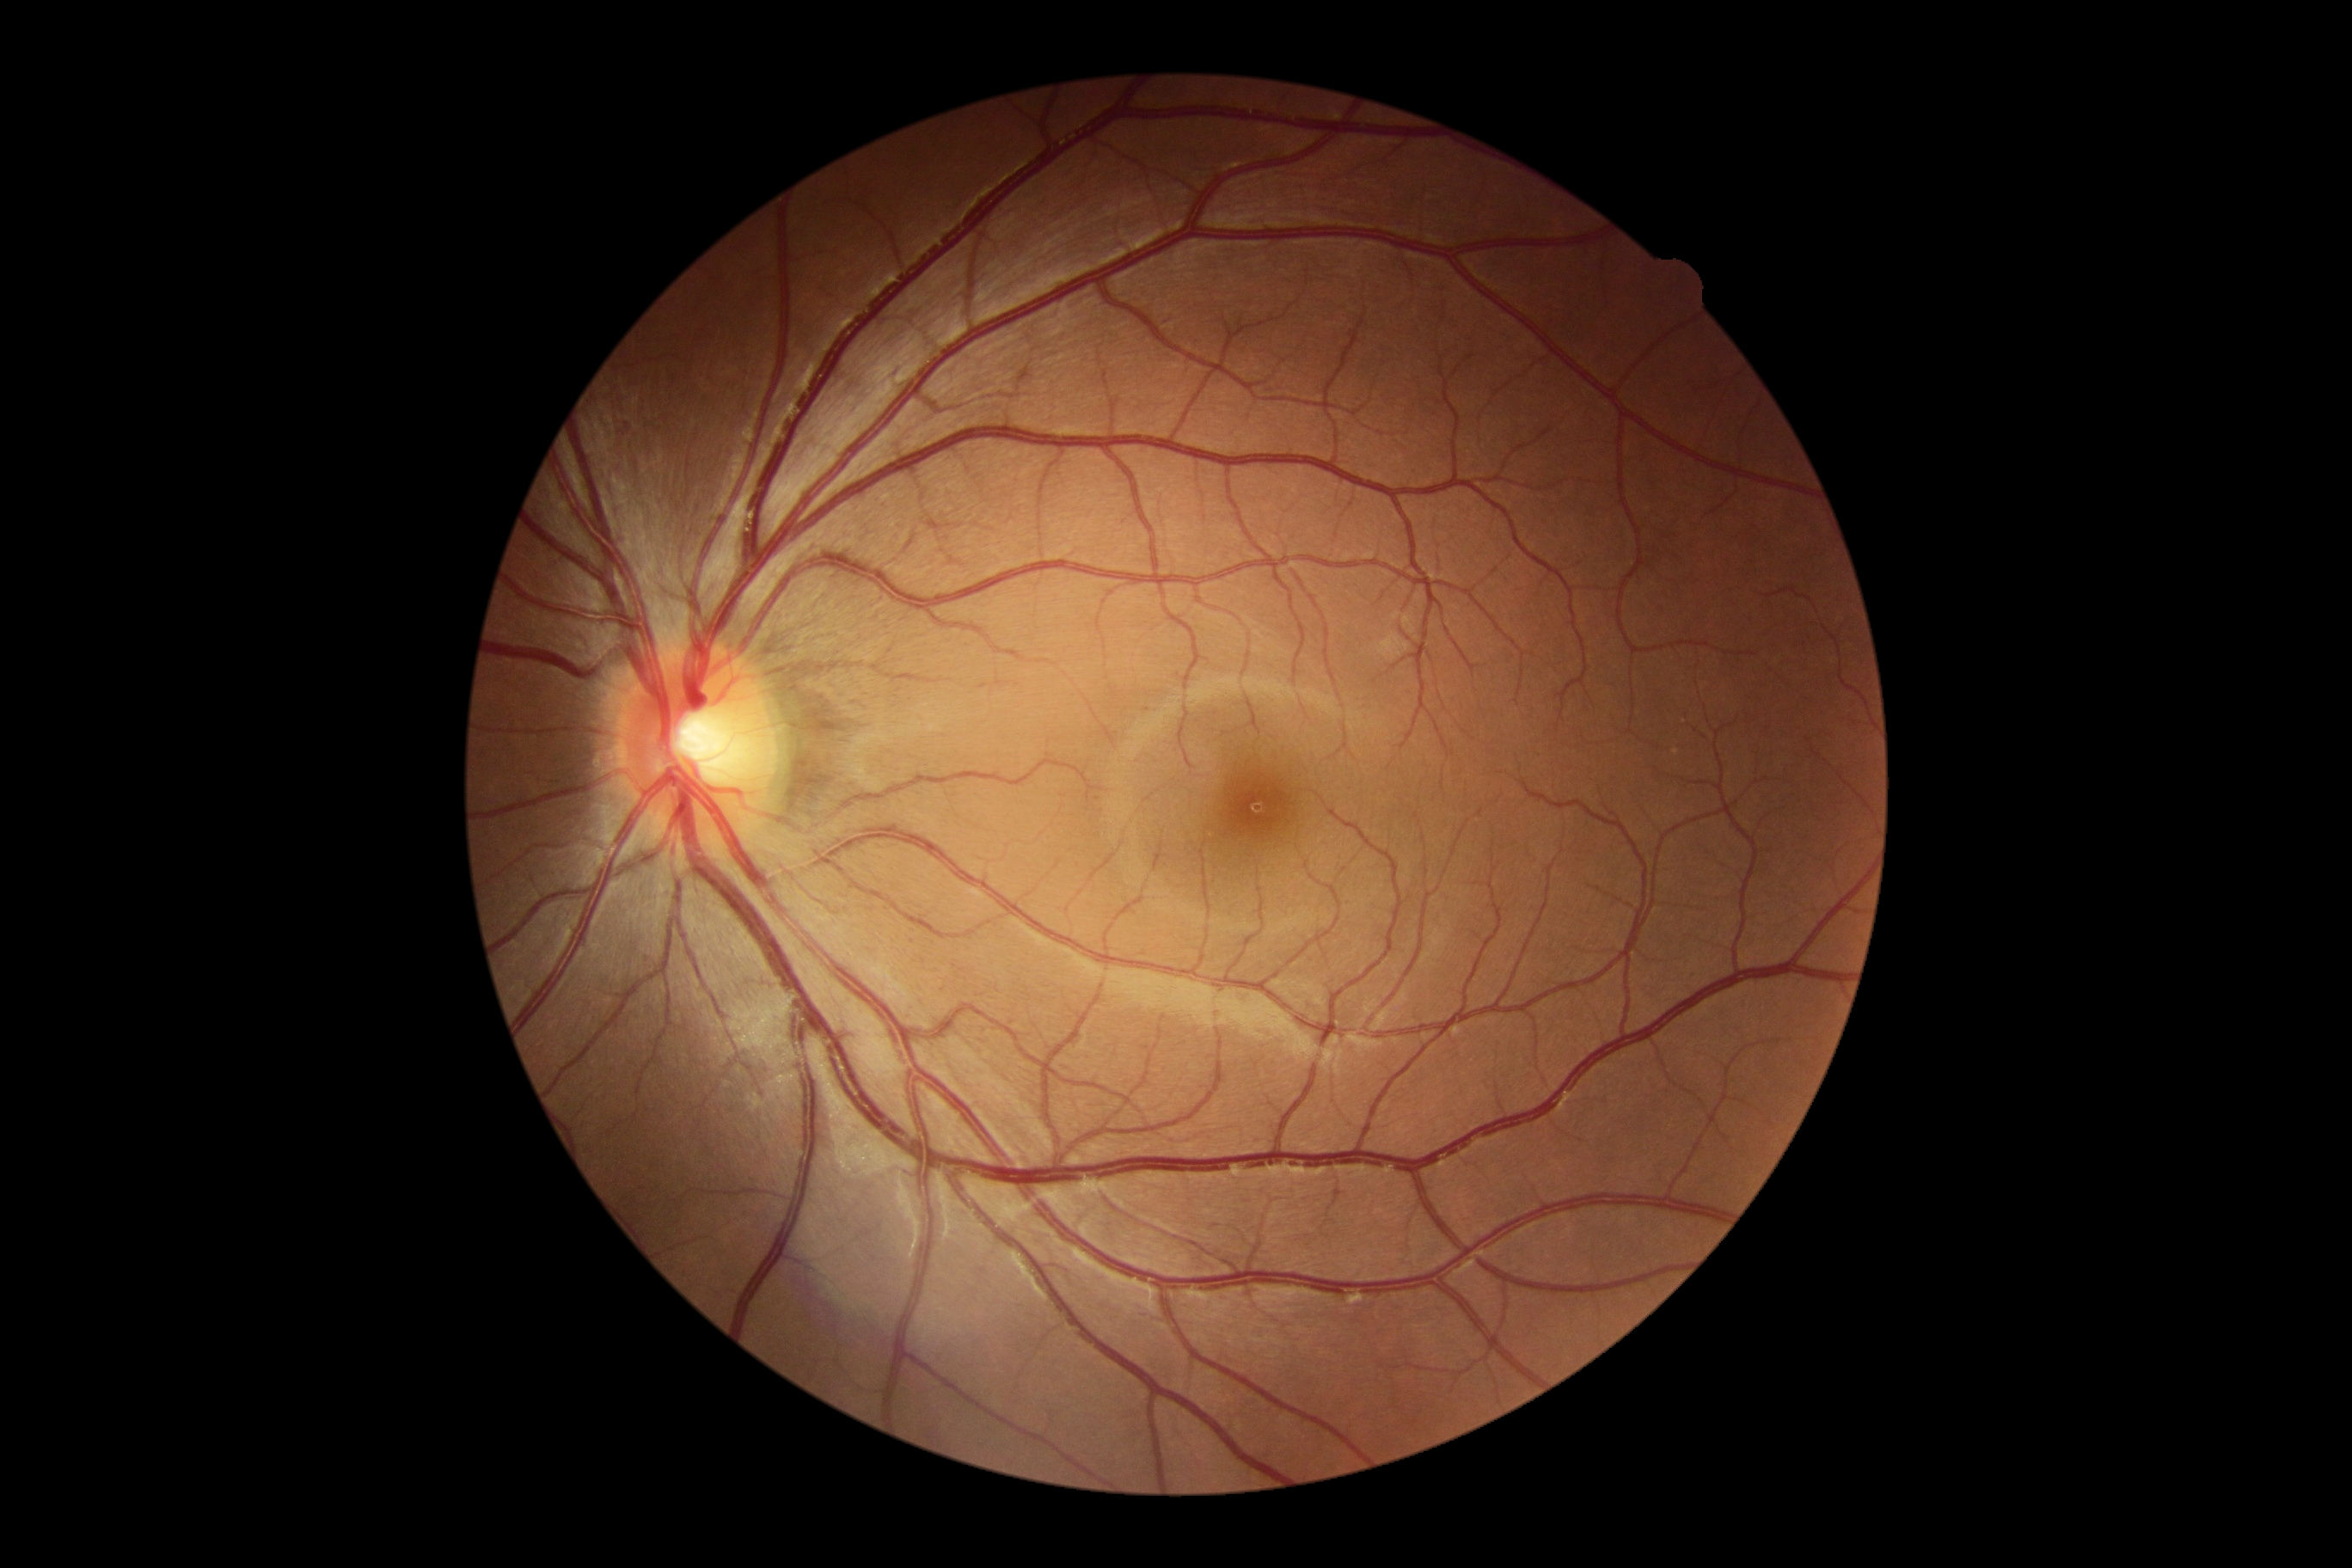

Diabetic retinopathy severity: grade 0 (no apparent retinopathy).